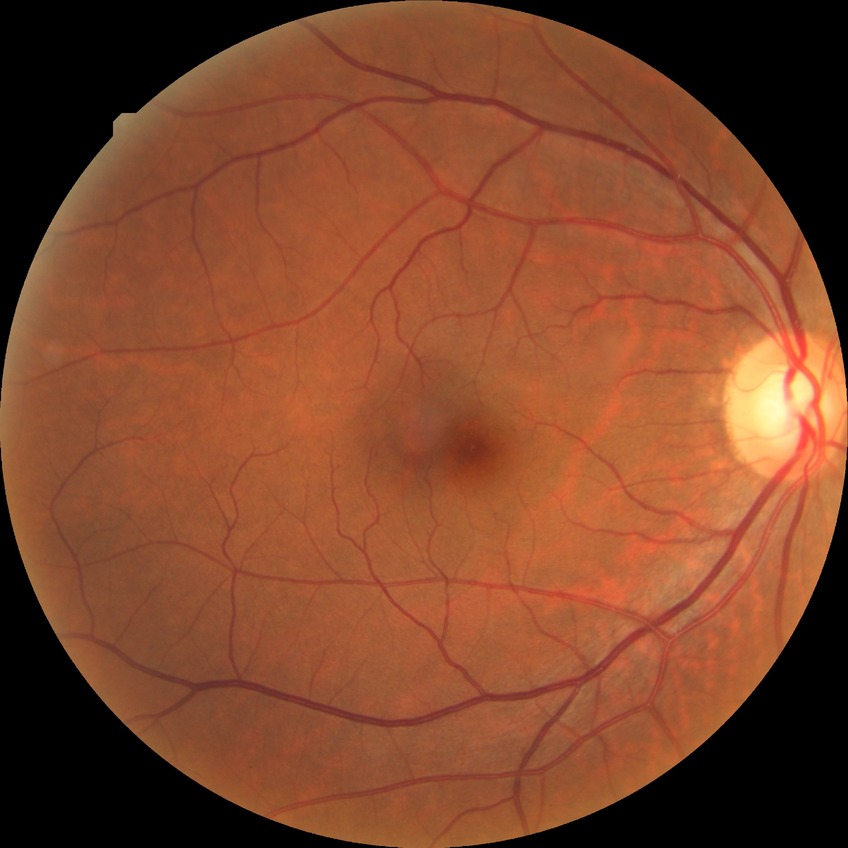

Retinopathy stage is no diabetic retinopathy.